Infant wide-field retinal image · acquired on the Phoenix ICON · 1240x1240 — 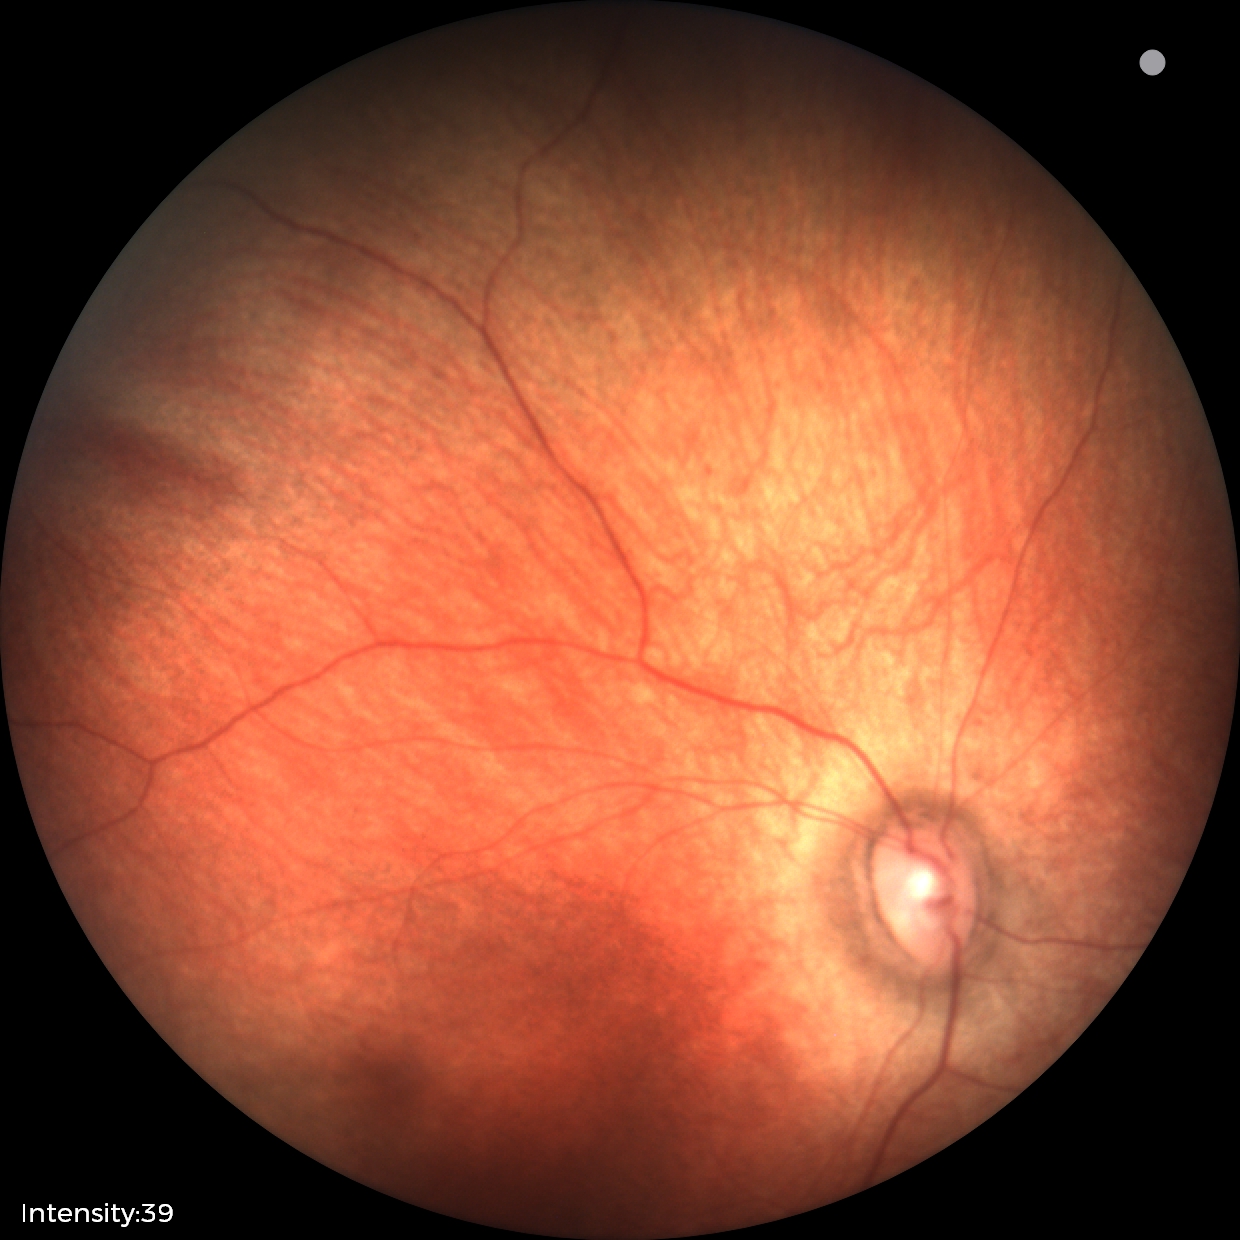
Diagnosis = physiological appearance.